50-degree field of view; 1932x1932px; captured after pupil dilation:
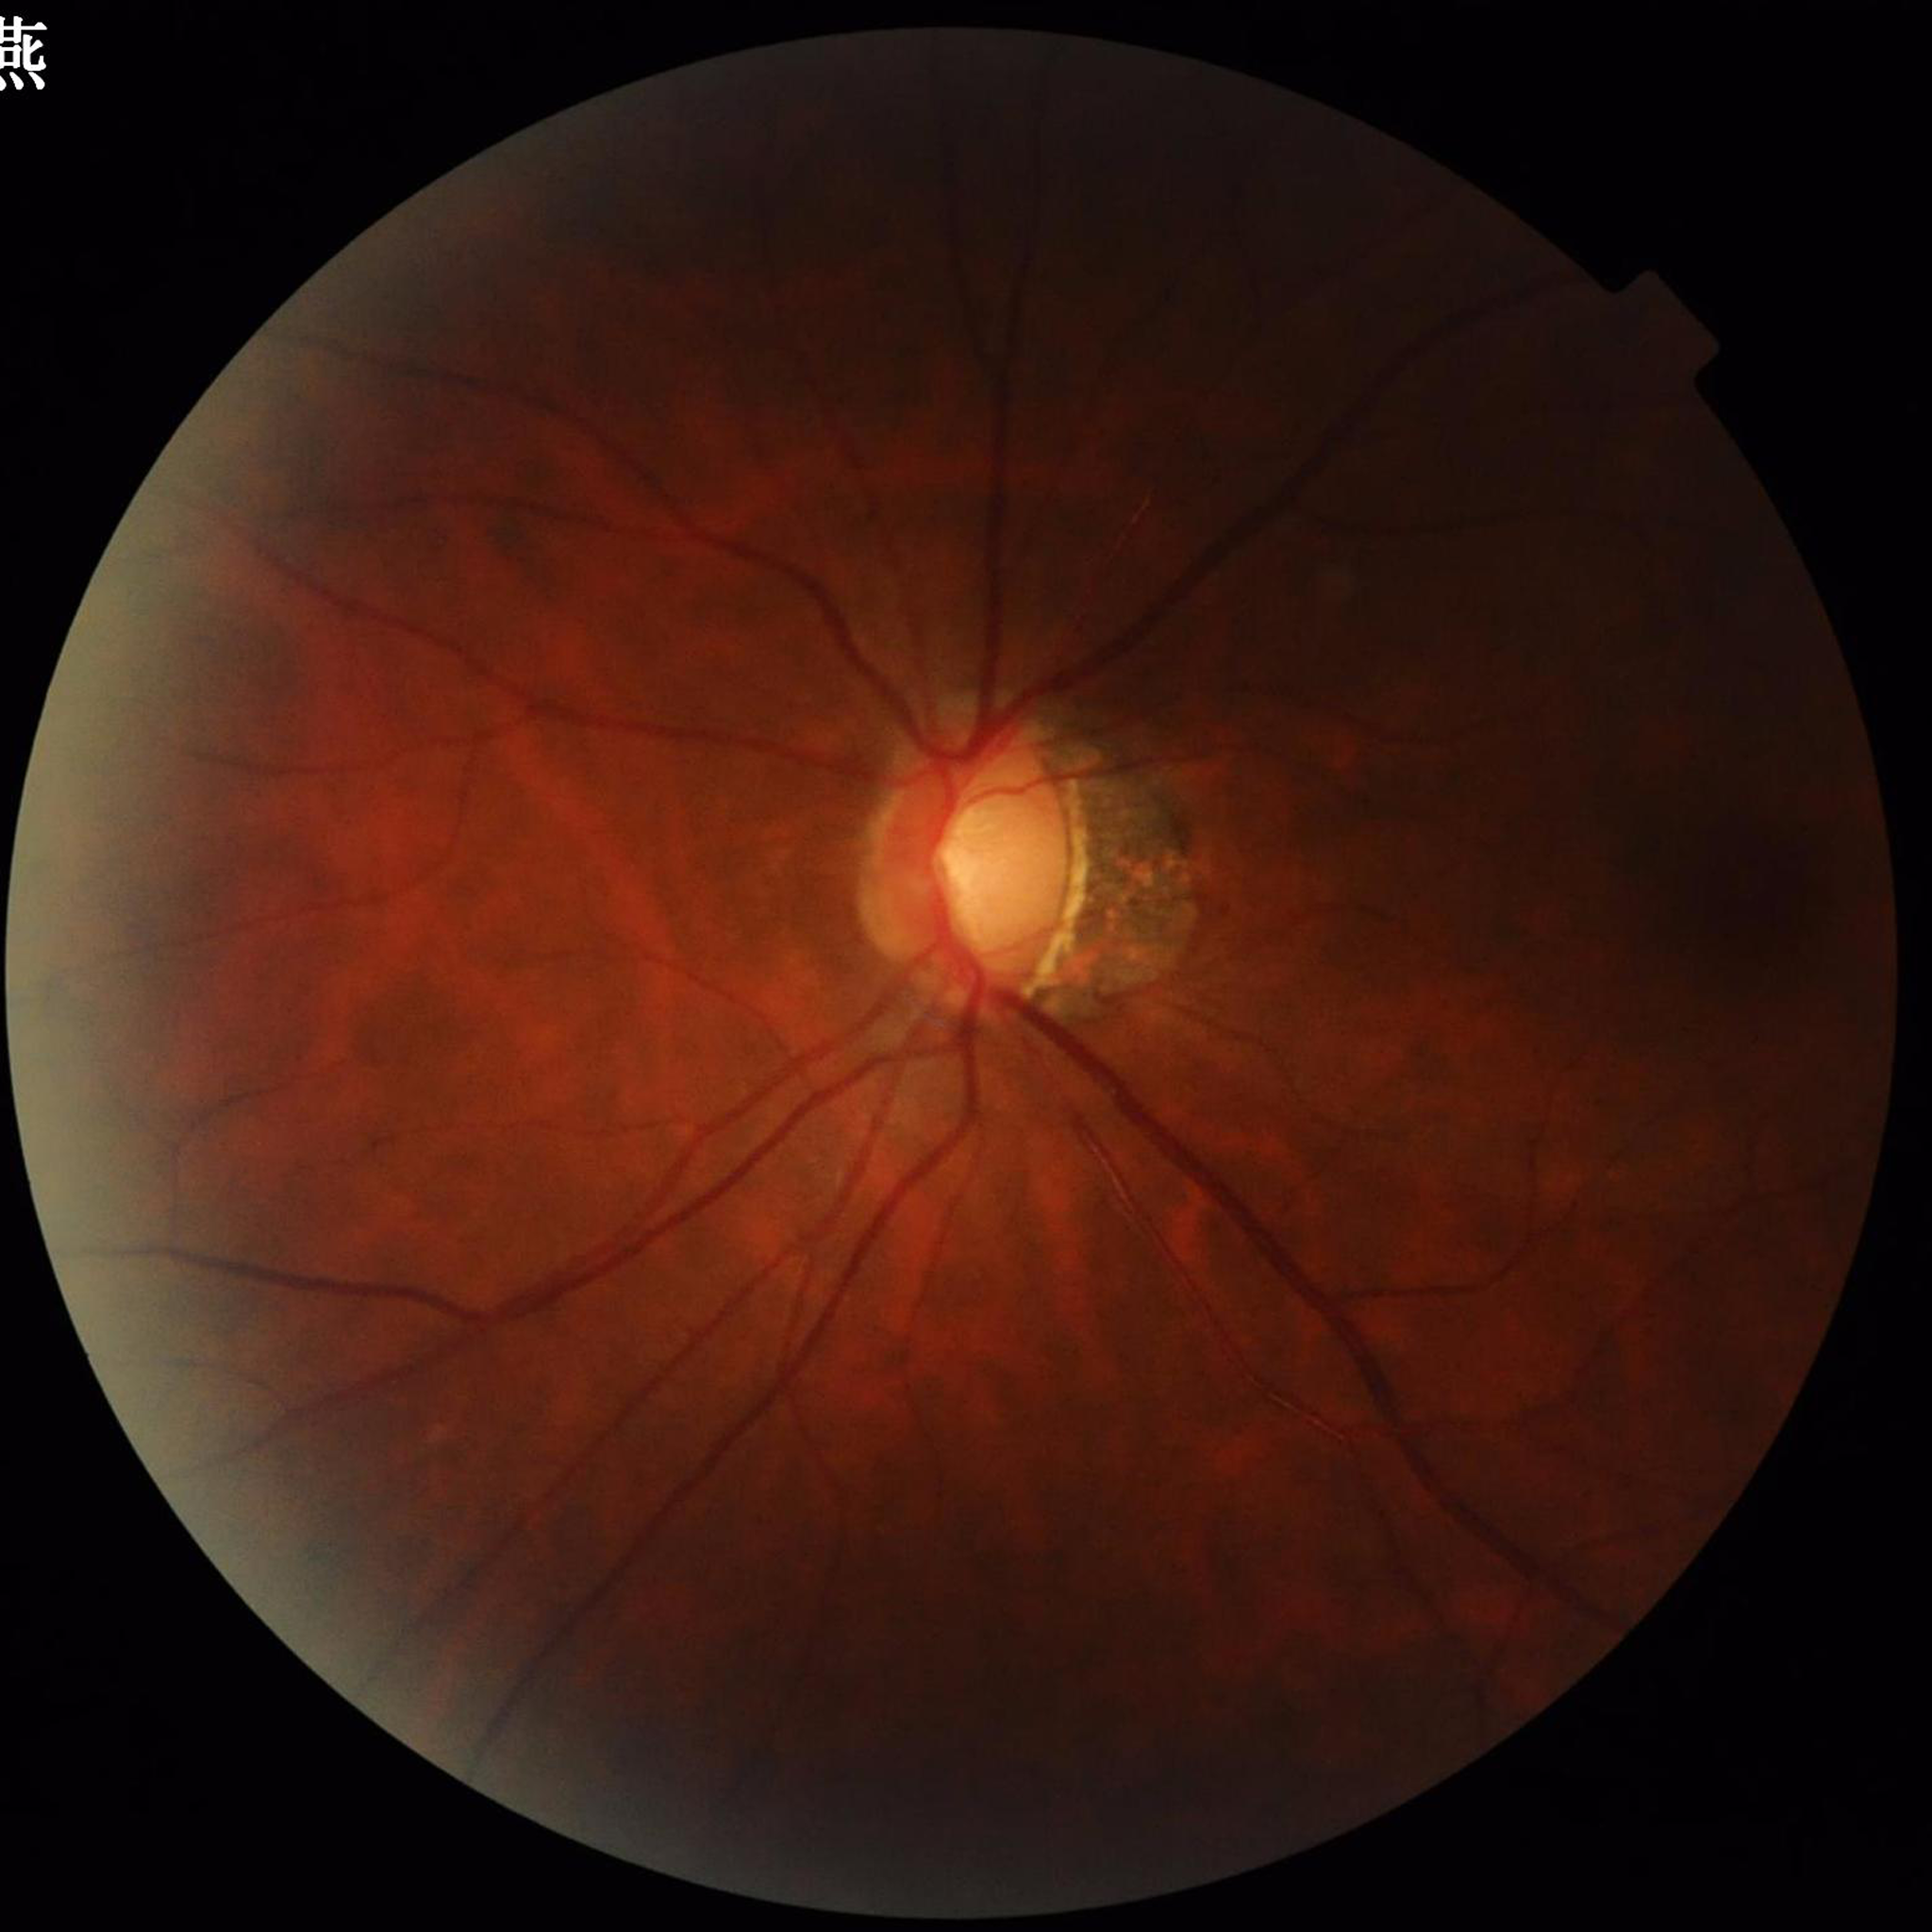 Quality assessment: poor — illumination/color distortion | Clinical diagnosis: glaucoma.